2212 by 1659 pixels — 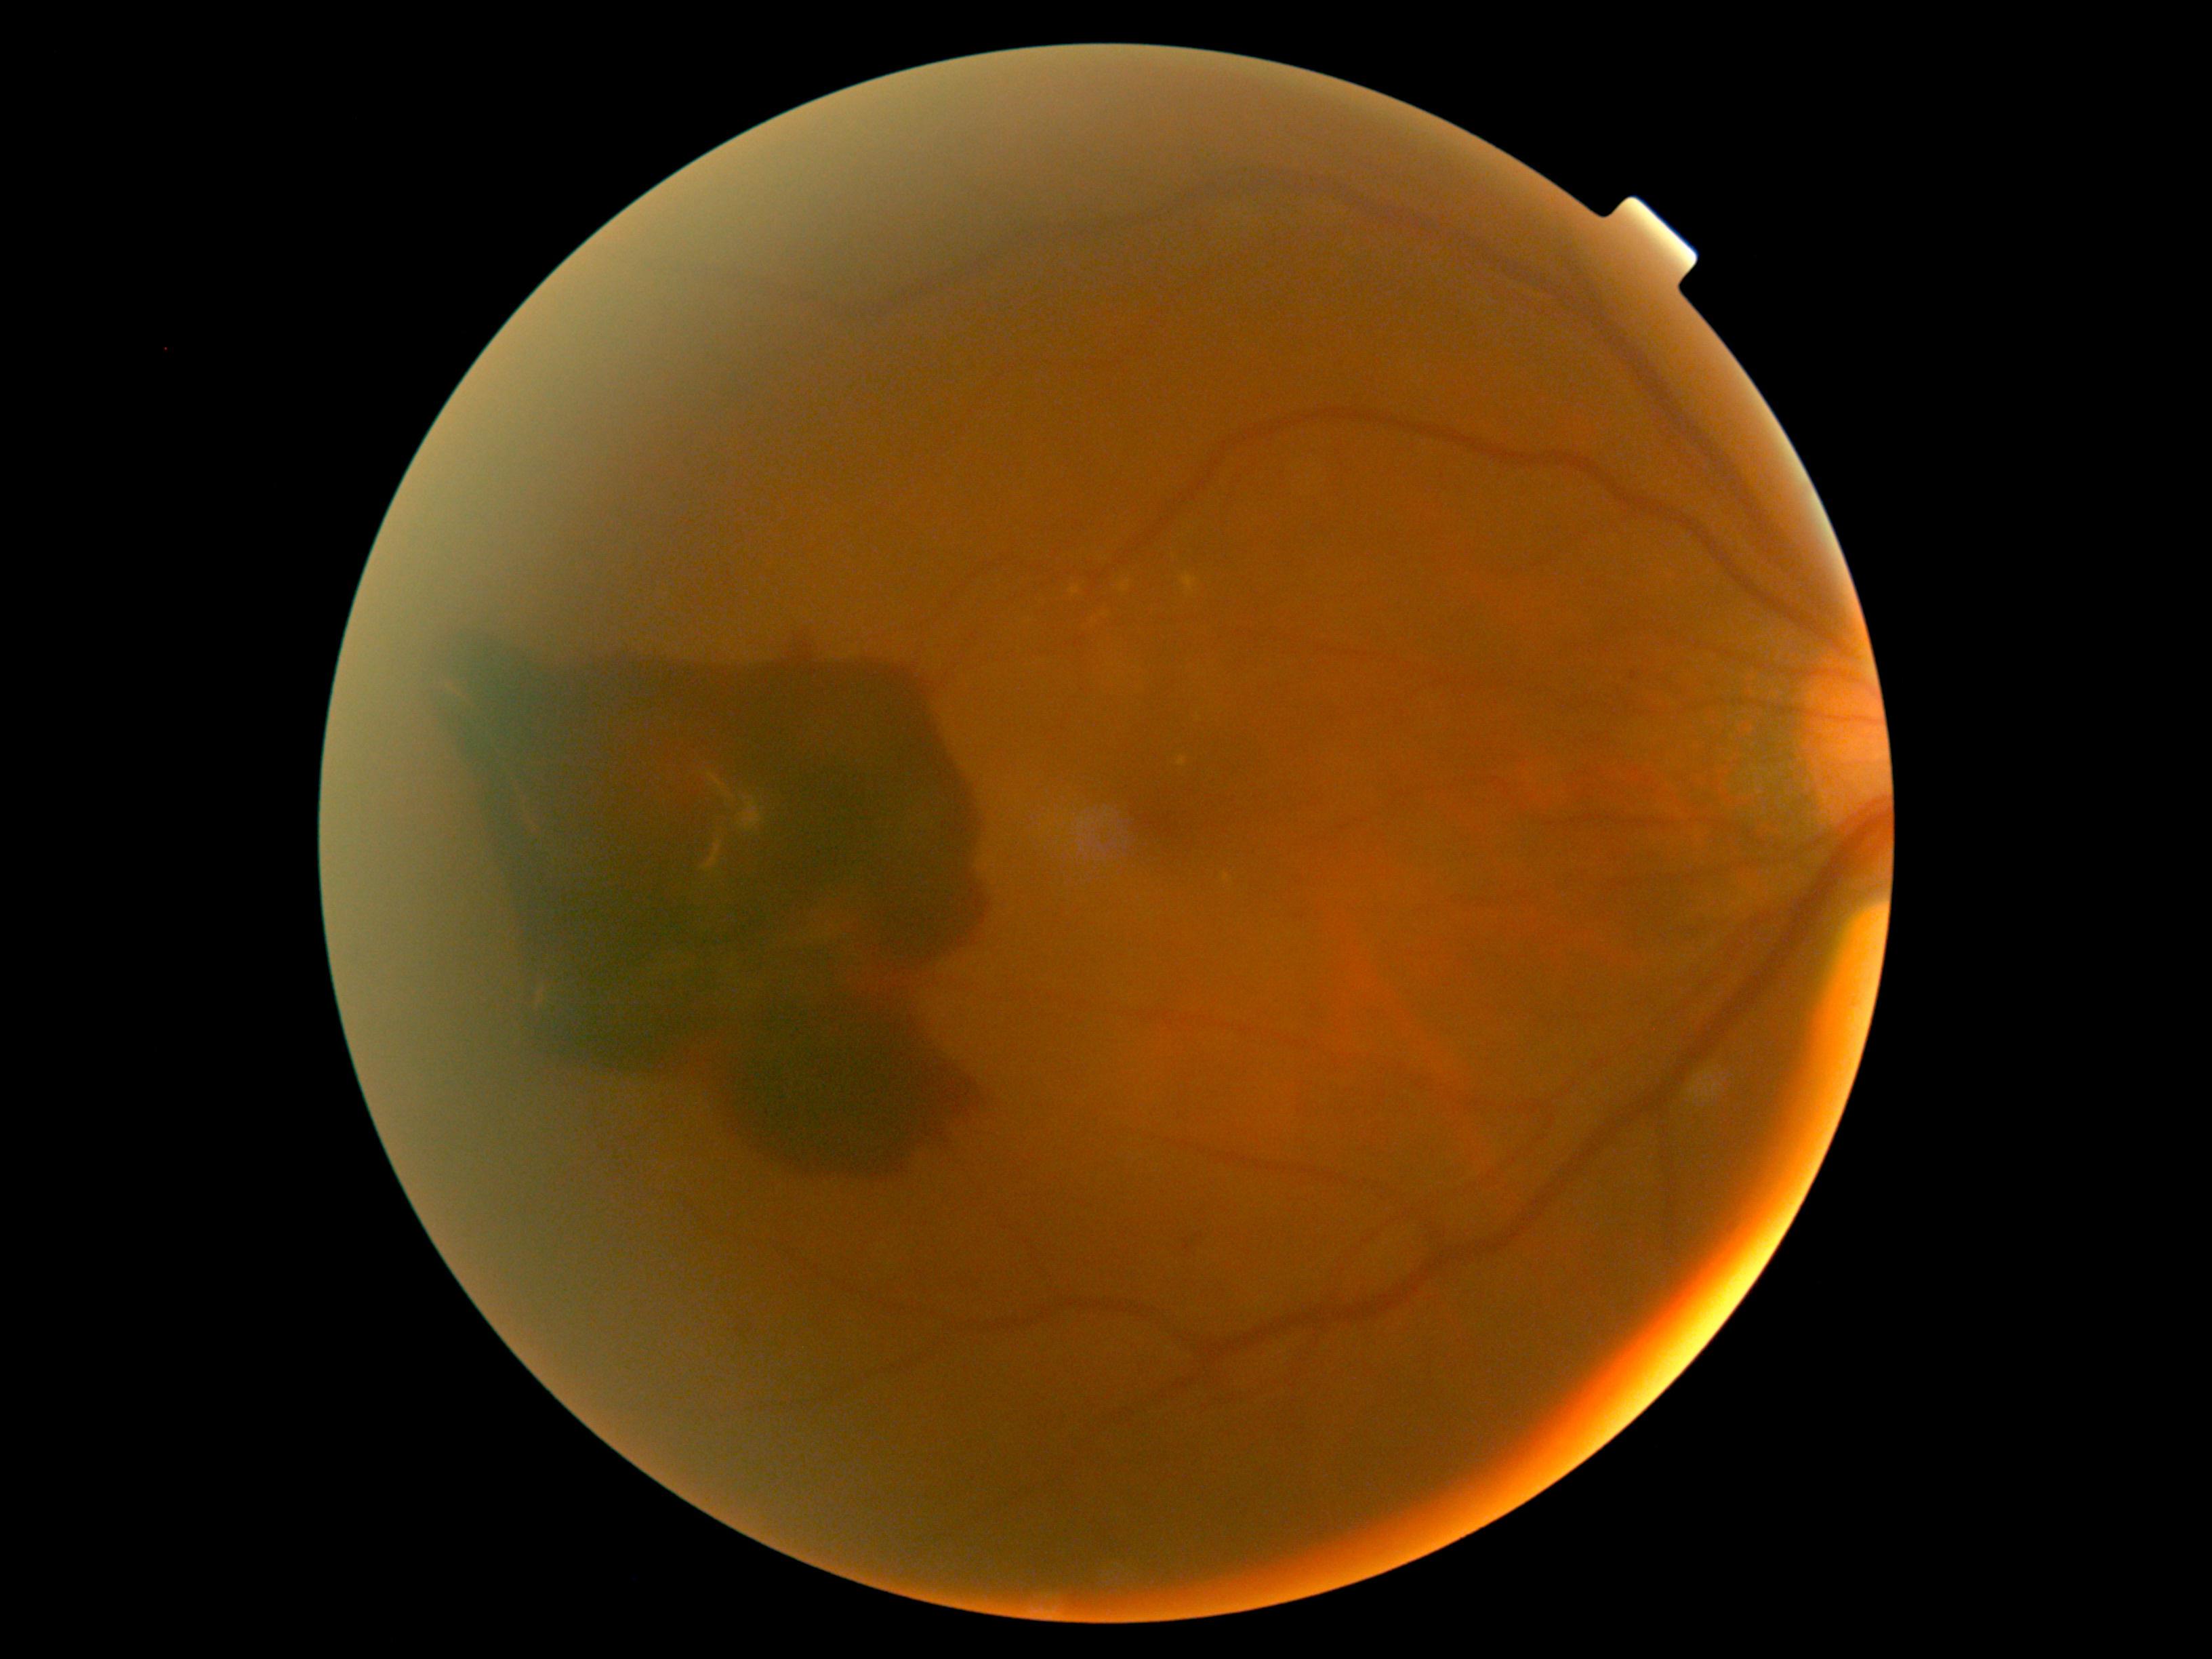

diabetic retinopathy (DR) = proliferative diabetic retinopathy (grade 4) — neovascularization and/or vitreous/pre-retinal hemorrhage